Optic disc region crop; non-mydriatic acquisition; CFP: 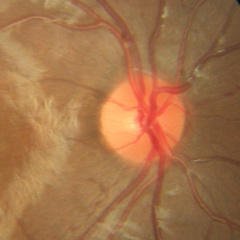 Impression = no glaucomatous findings.